Wide-field fundus image from infant ROP screening. 1240 by 1240 pixels:
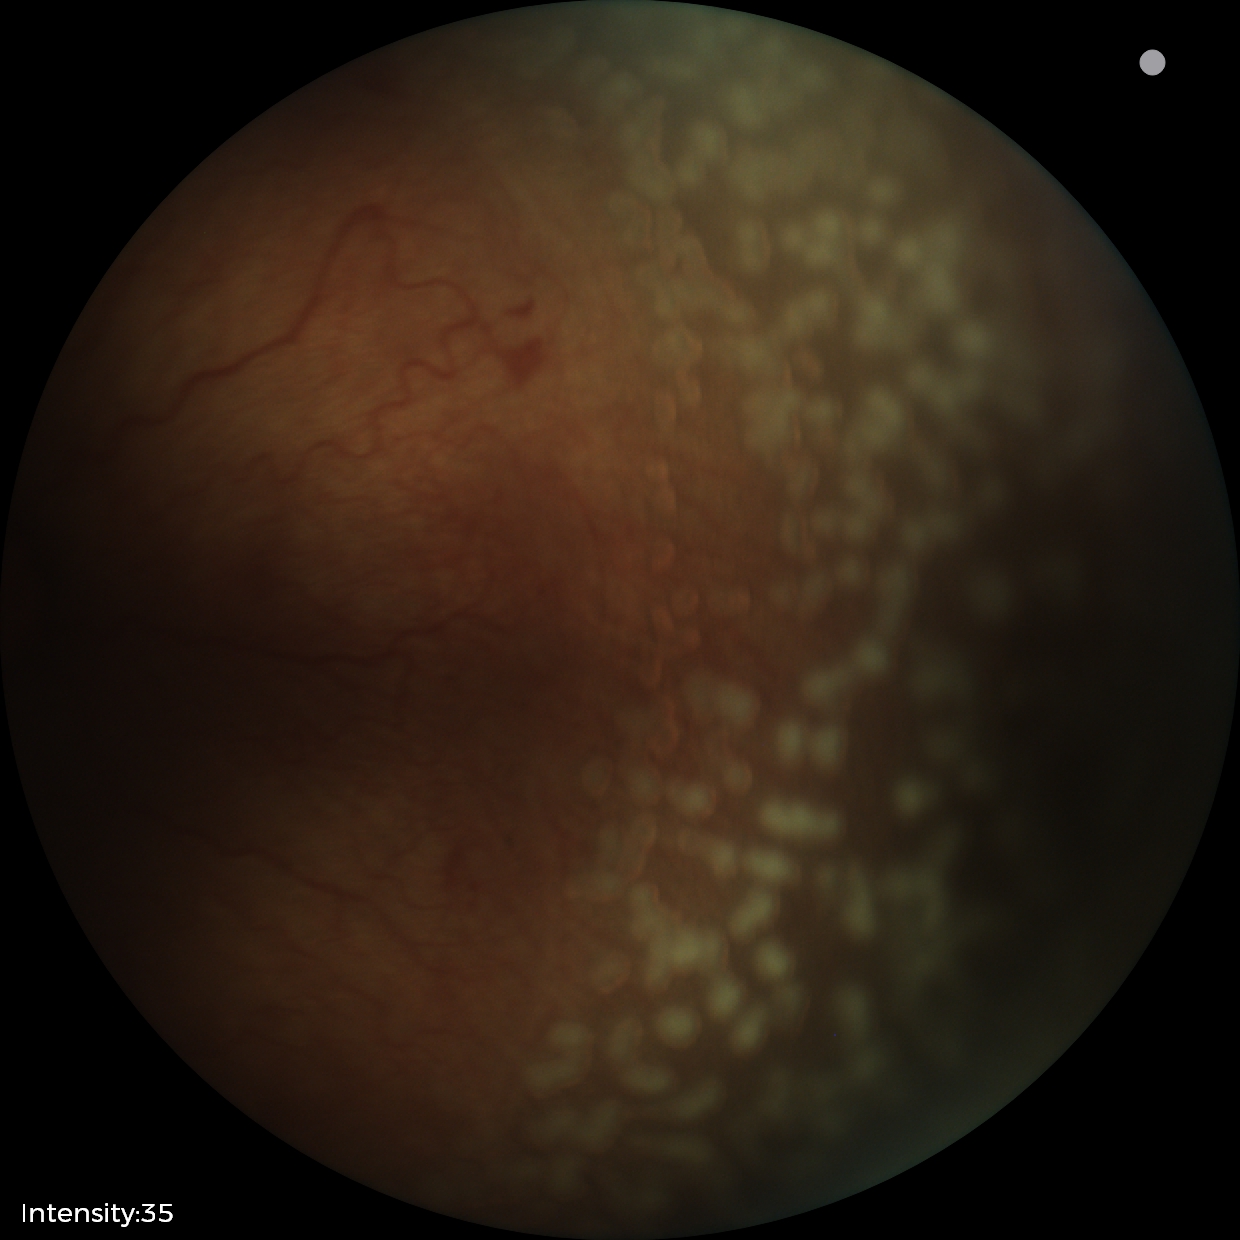

Screening diagnosis: retinopathy of prematurity (ROP) stage 2.